Wide-field fundus photograph from neonatal ROP screening. Image size 1240x1240
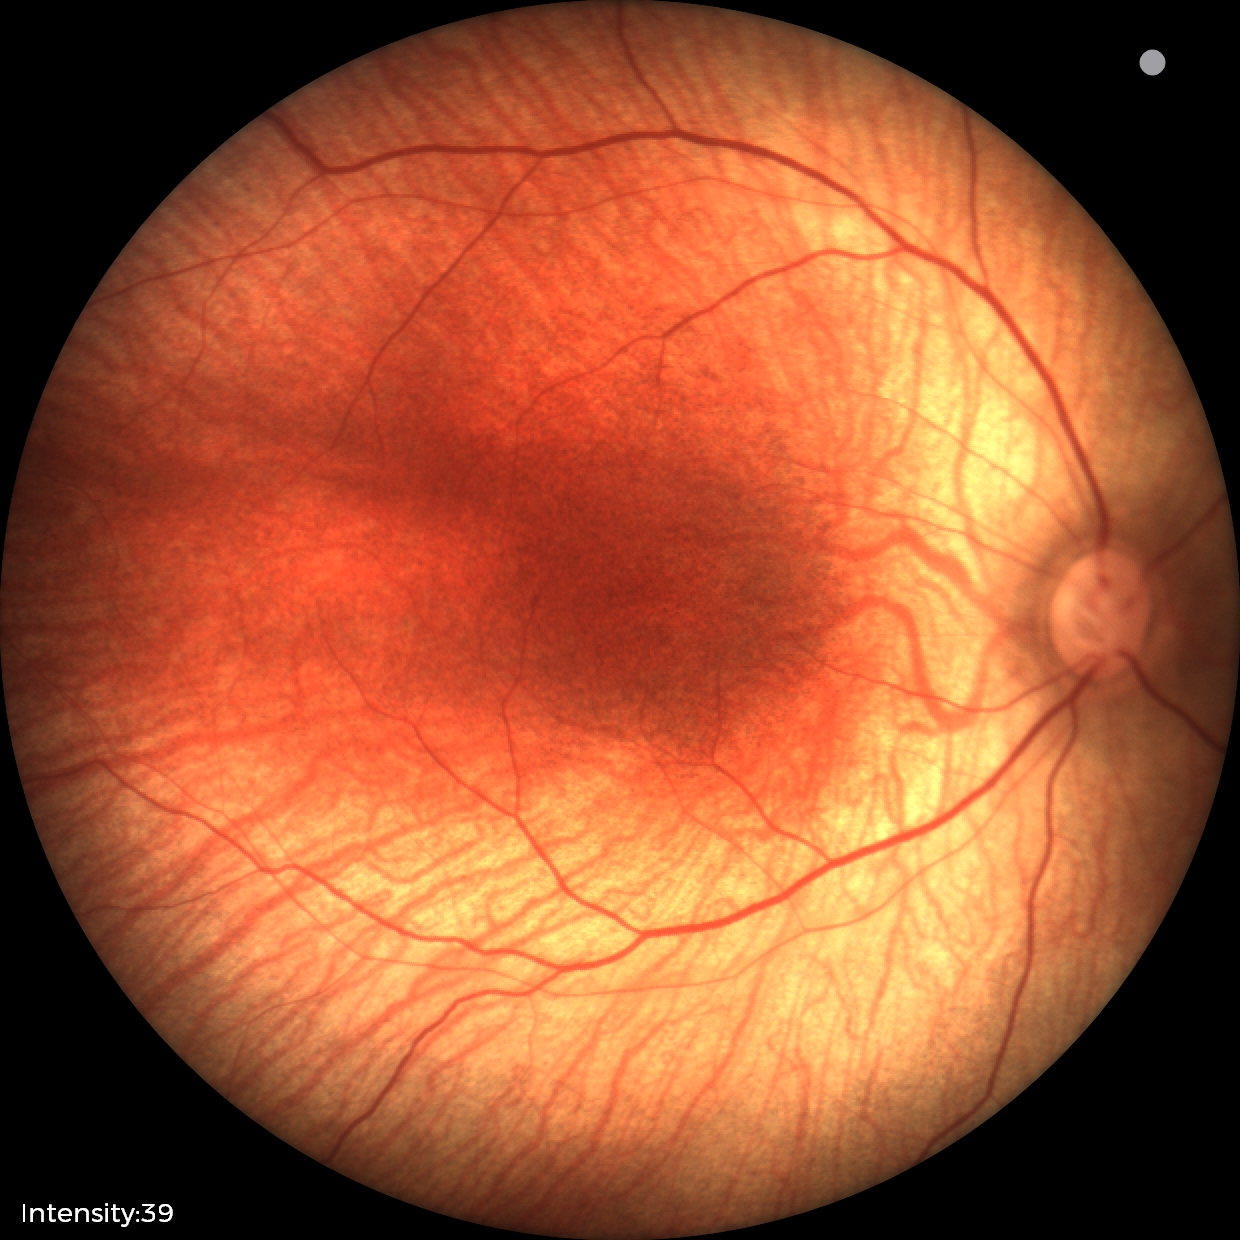 Screening examination diagnosed as physiological.